640x480px. Wide-field fundus image from infant ROP screening.
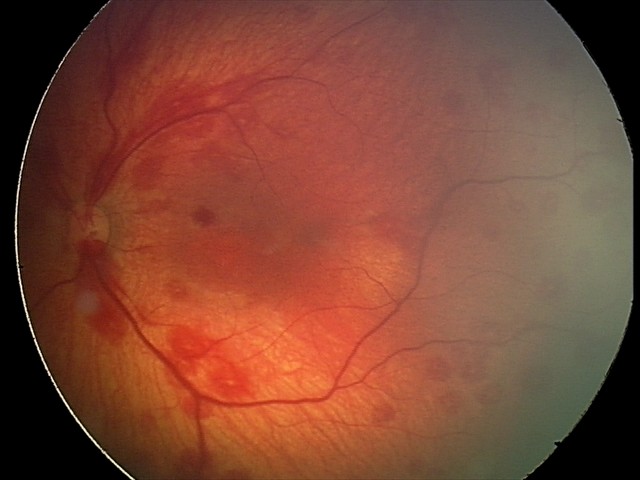

Screening examination consistent with retinal hemorrhages.